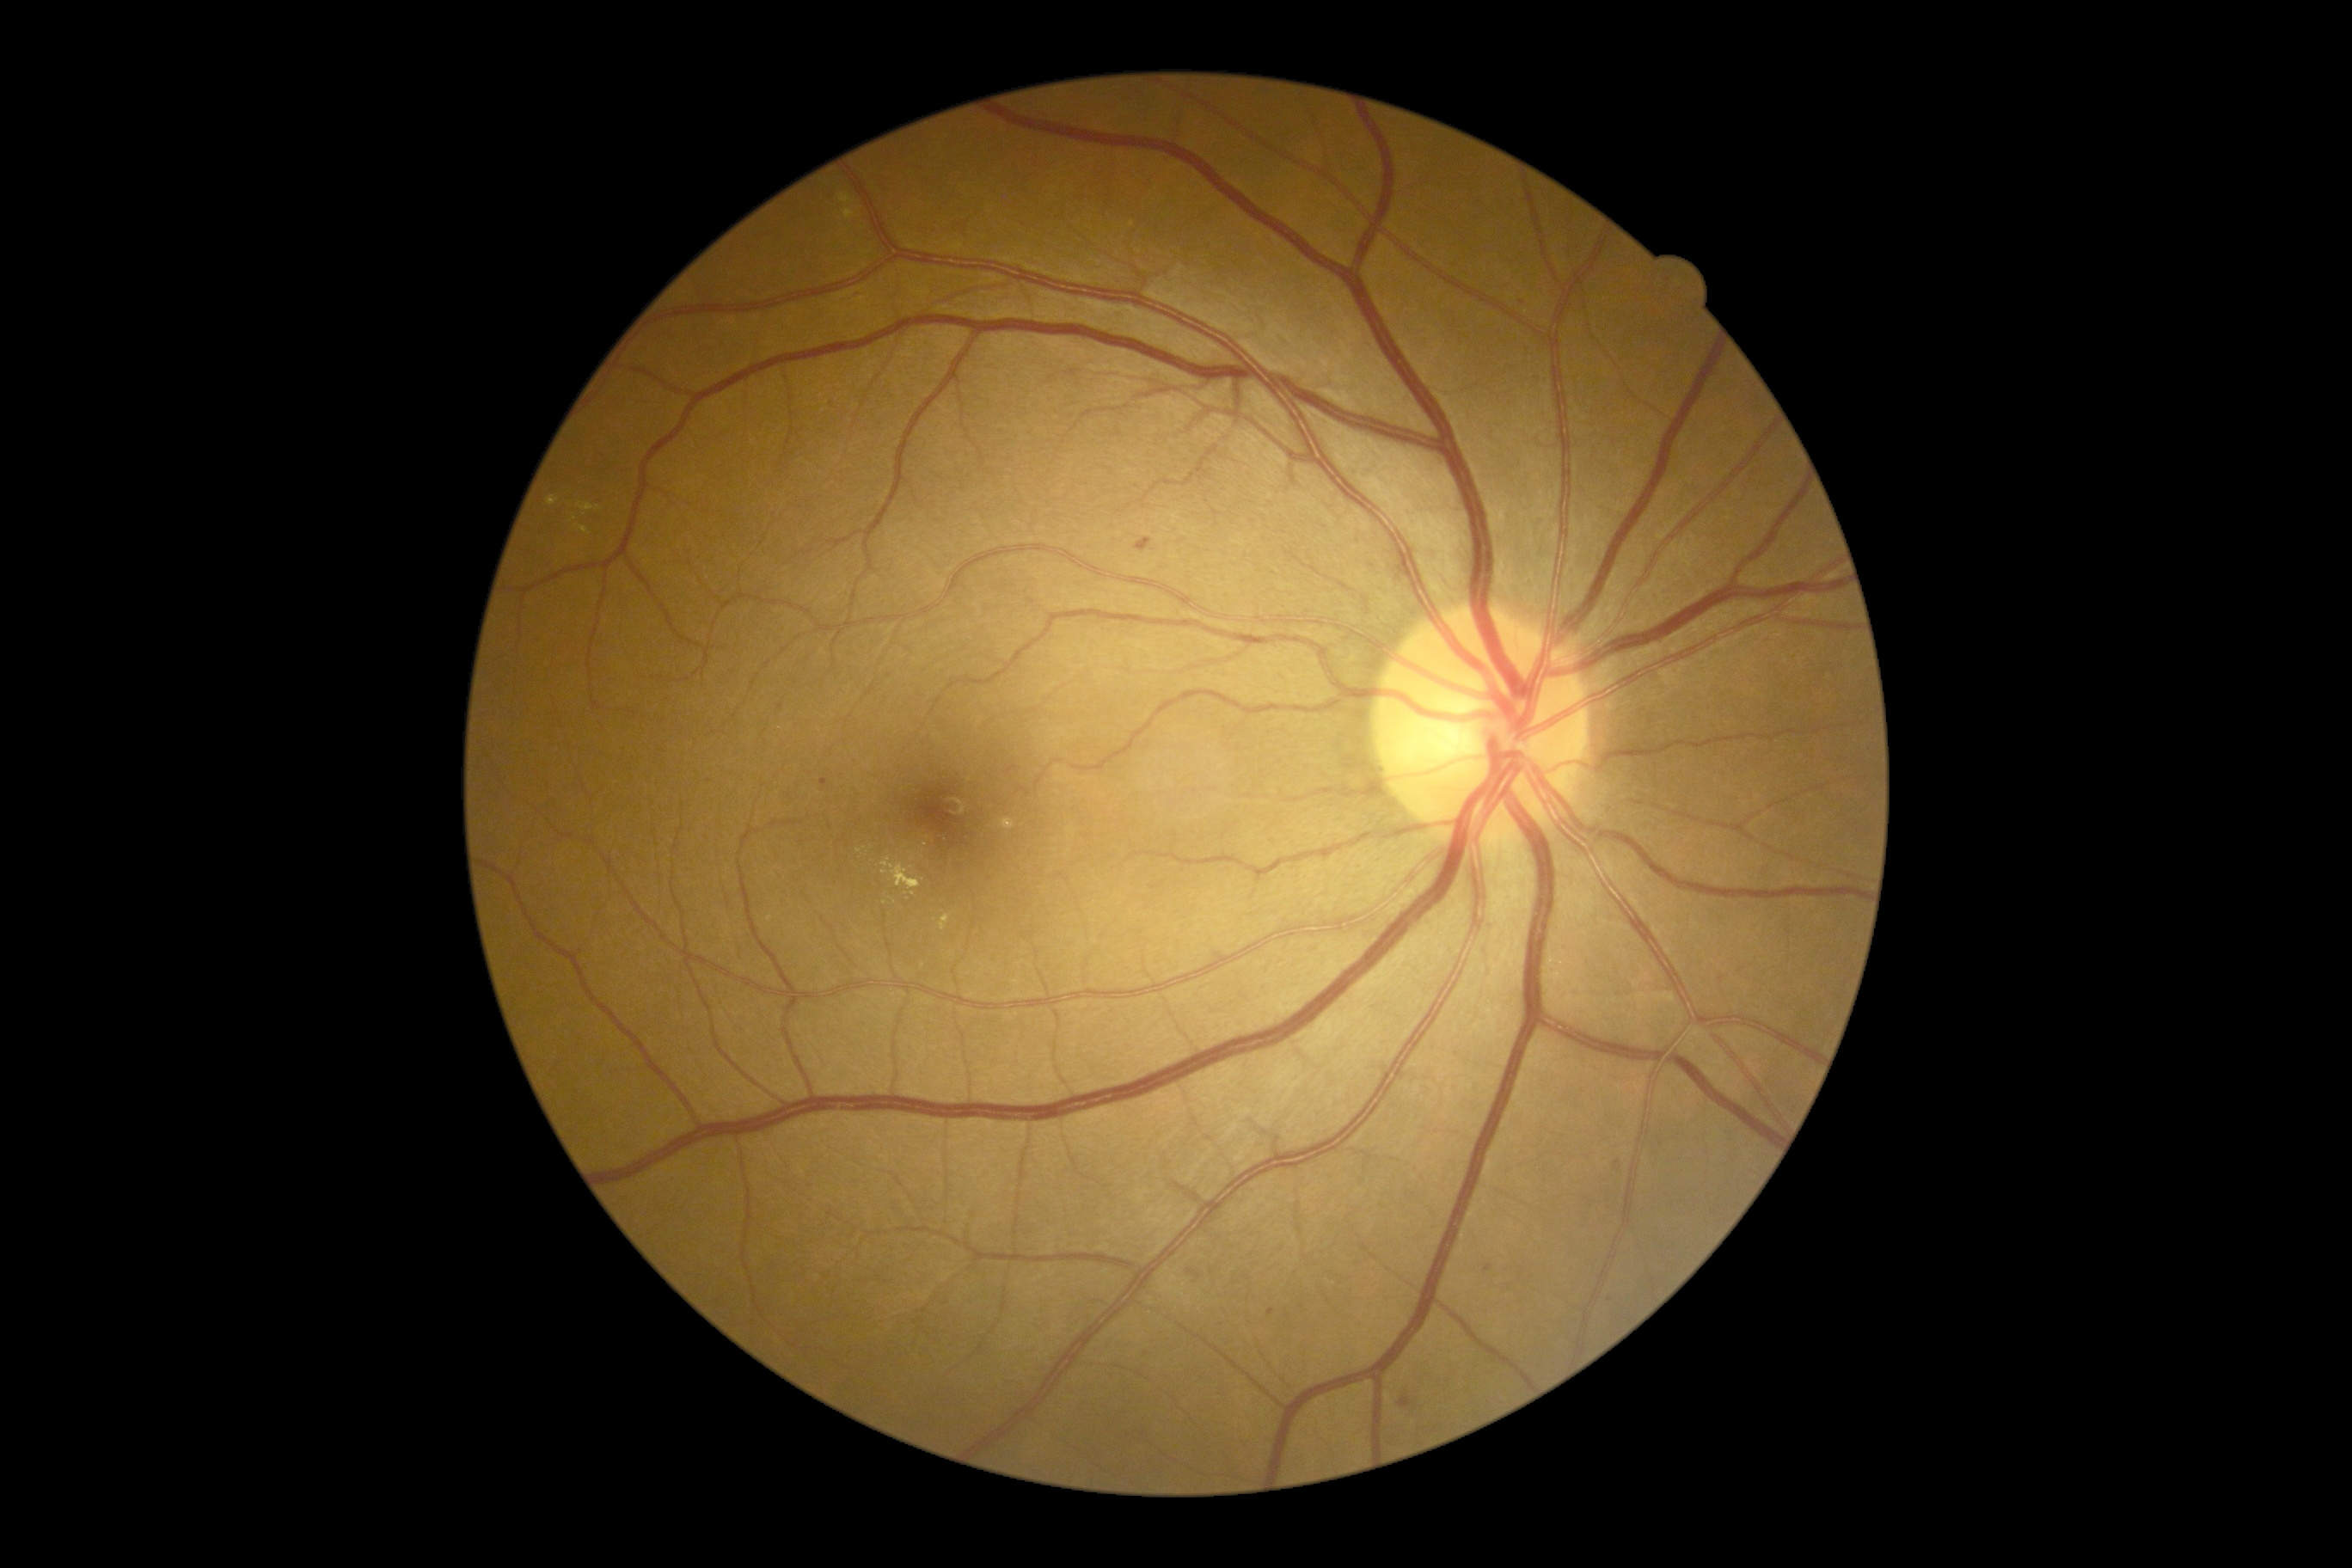
DR: moderate non-proliferative diabetic retinopathy (grade 2).
The retinopathy is classified as non-proliferative diabetic retinopathy.